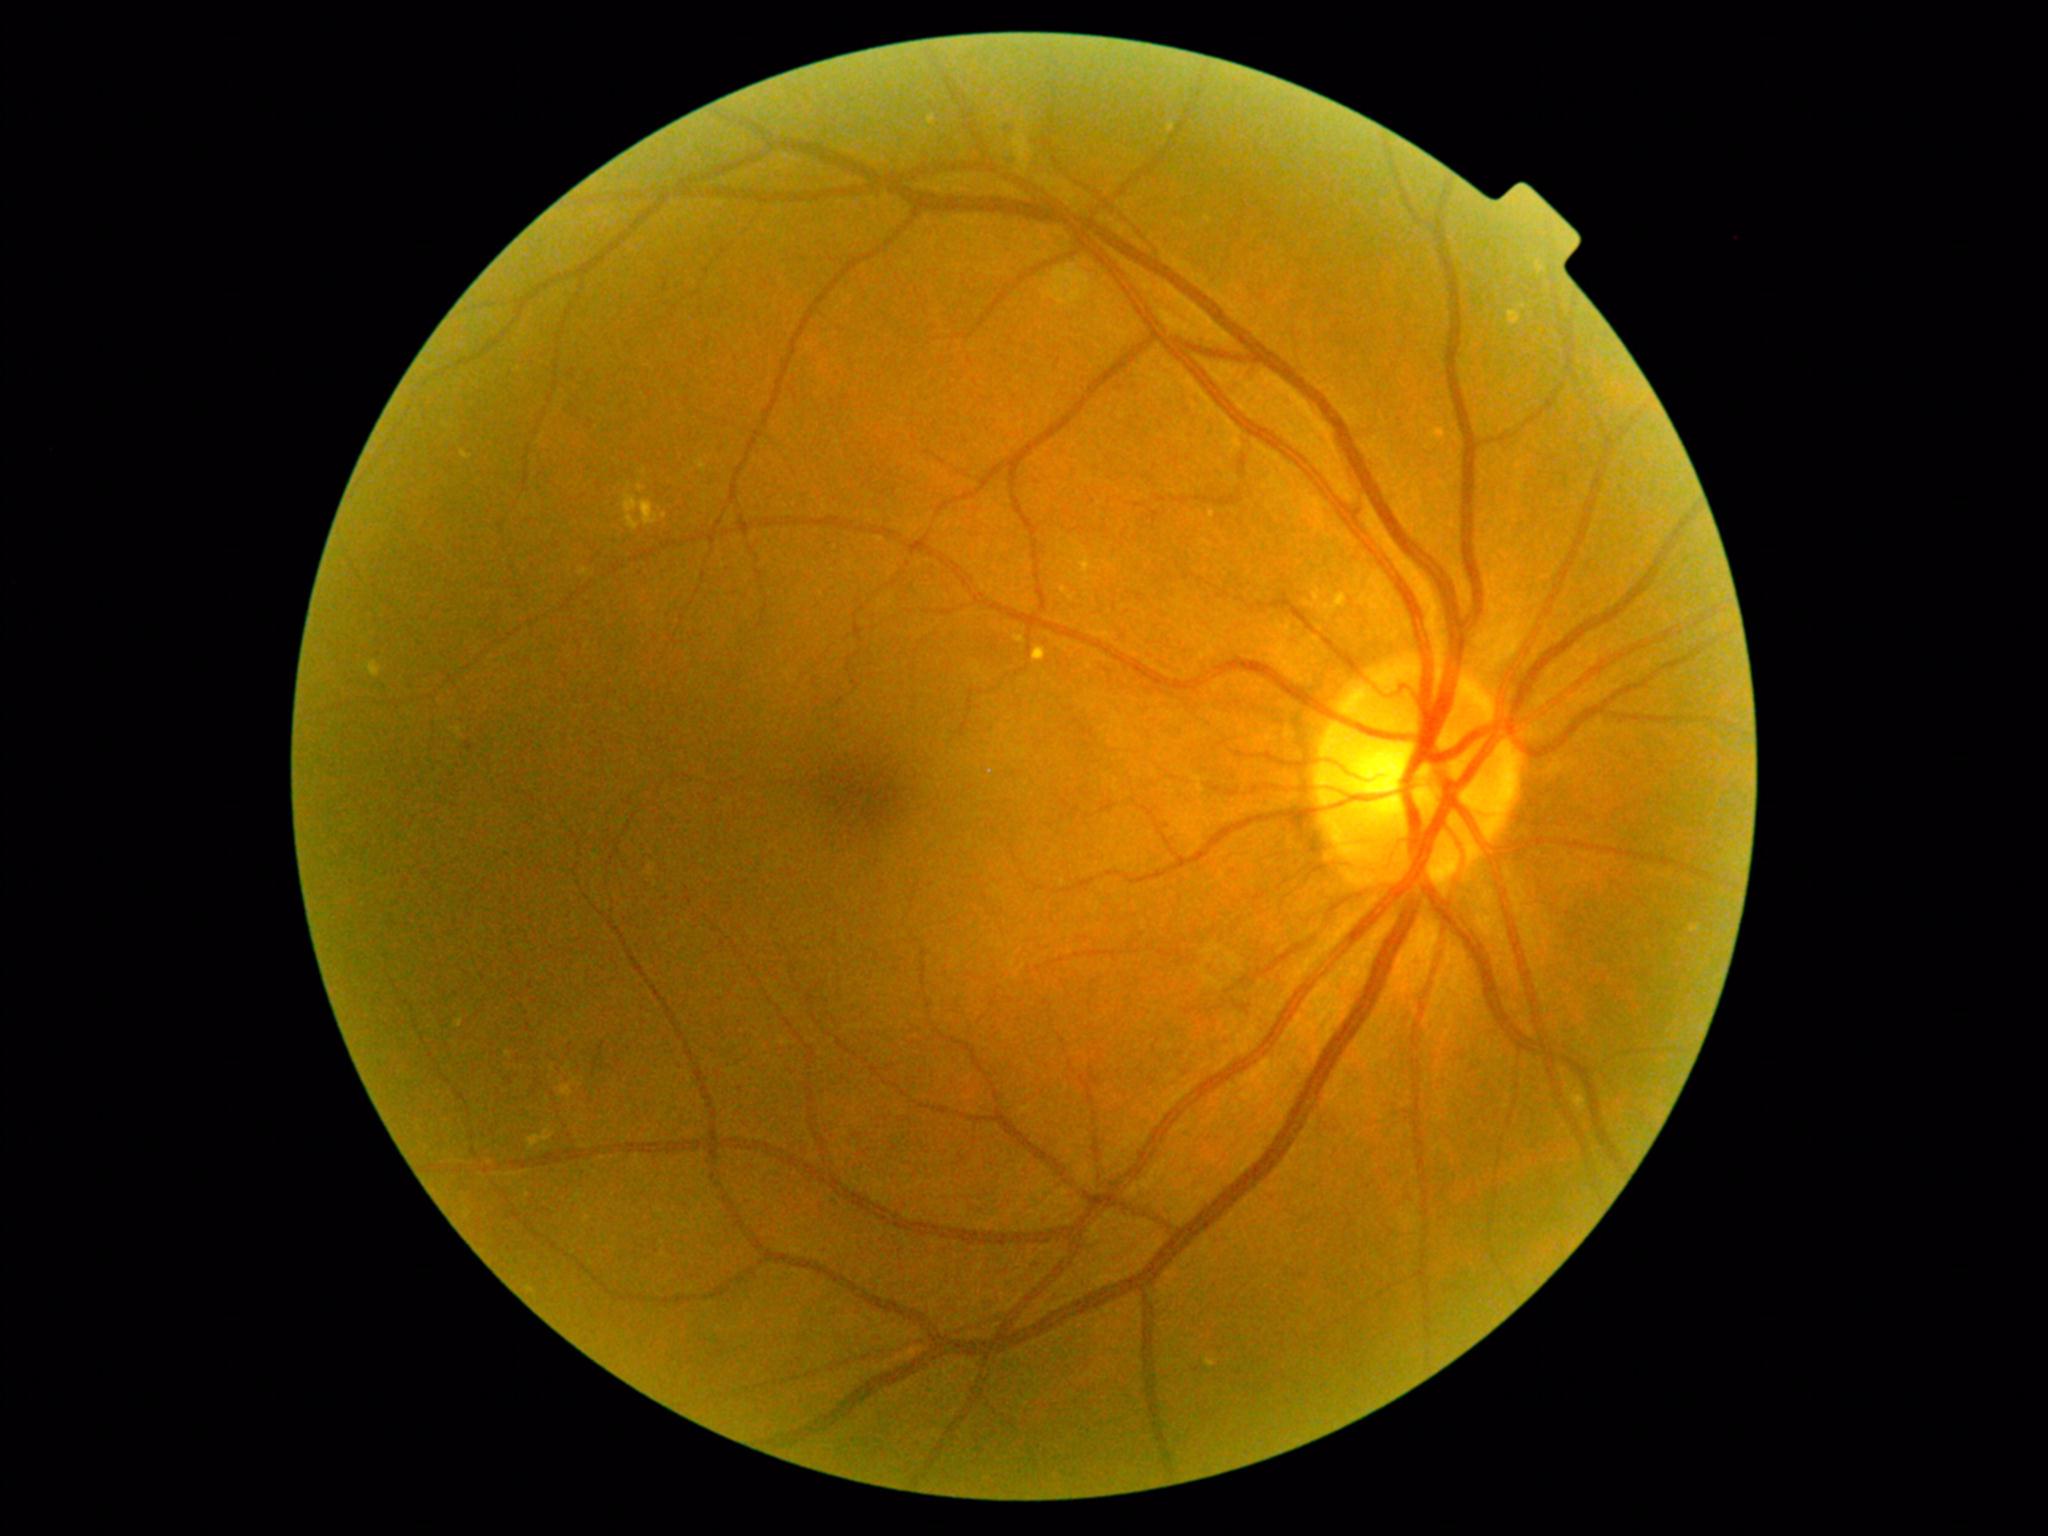 {"partial": true, "dr_grade": 2, "lesions": {"se": null, "ex": [[366, 661, 381, 678], [1690, 925, 1701, 933], [1033, 647, 1047, 662], [1205, 216, 1212, 224], [624, 493, 658, 529], [526, 1286, 535, 1293], [1205, 1359, 1216, 1368], [455, 1016, 463, 1028], [1312, 587, 1321, 604], [462, 450, 472, 460]], "ex_small_centers": [[644, 472], [664, 516]], "he": null, "ma": null}}